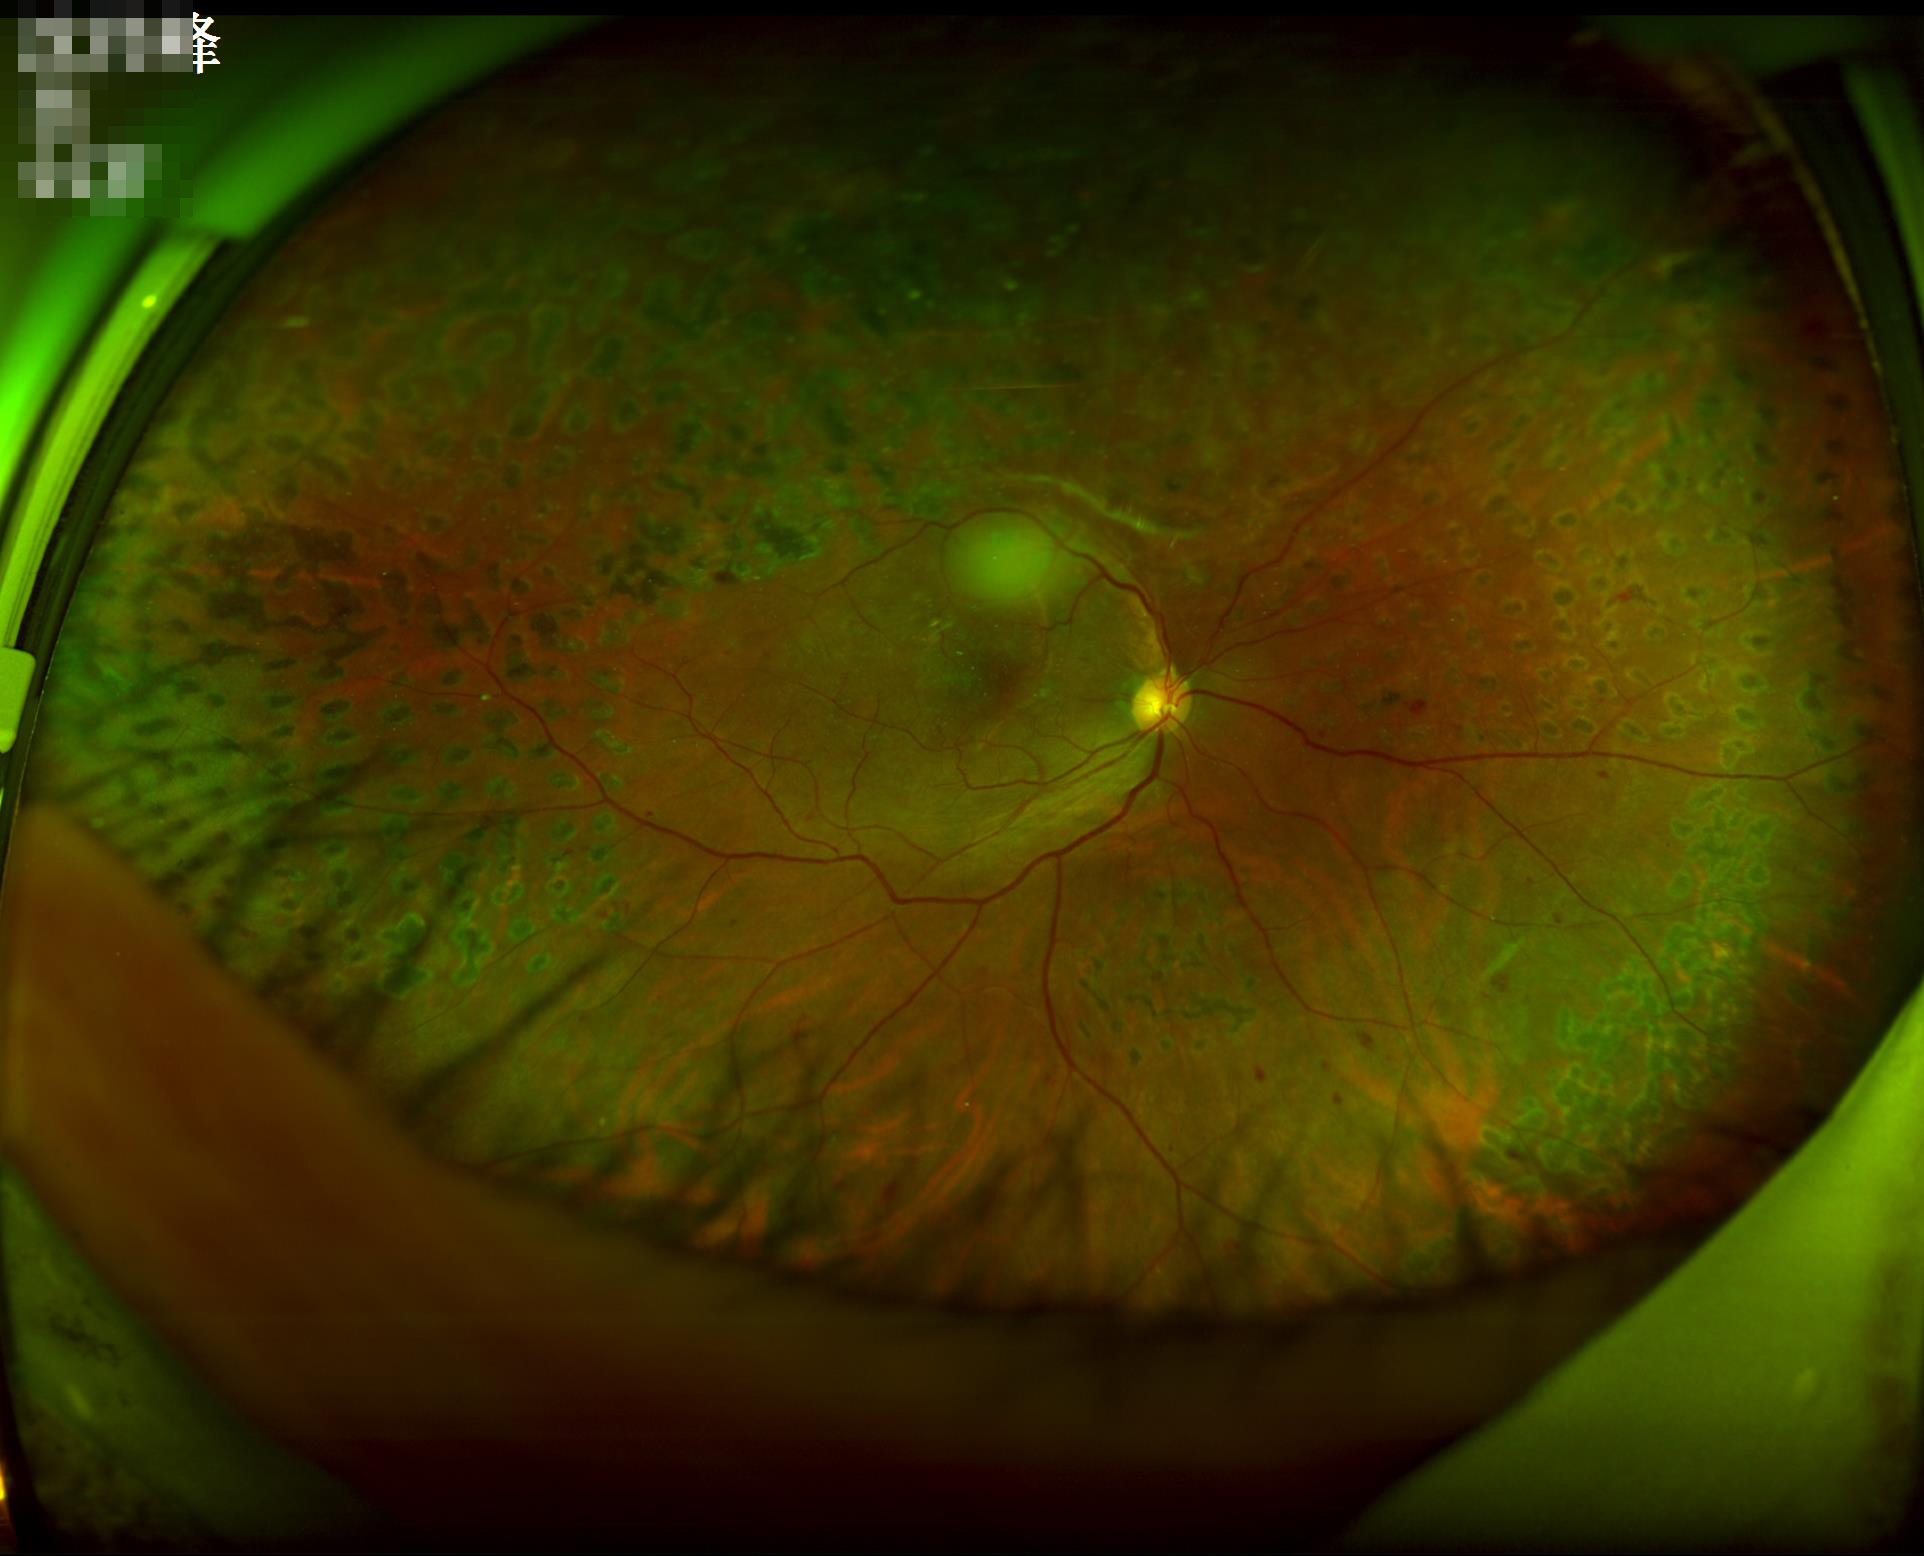 Vessels and details are readily distinguishable.
Acceptable image quality.
The image is clear.
No over- or under-exposure.